1659x2212px.
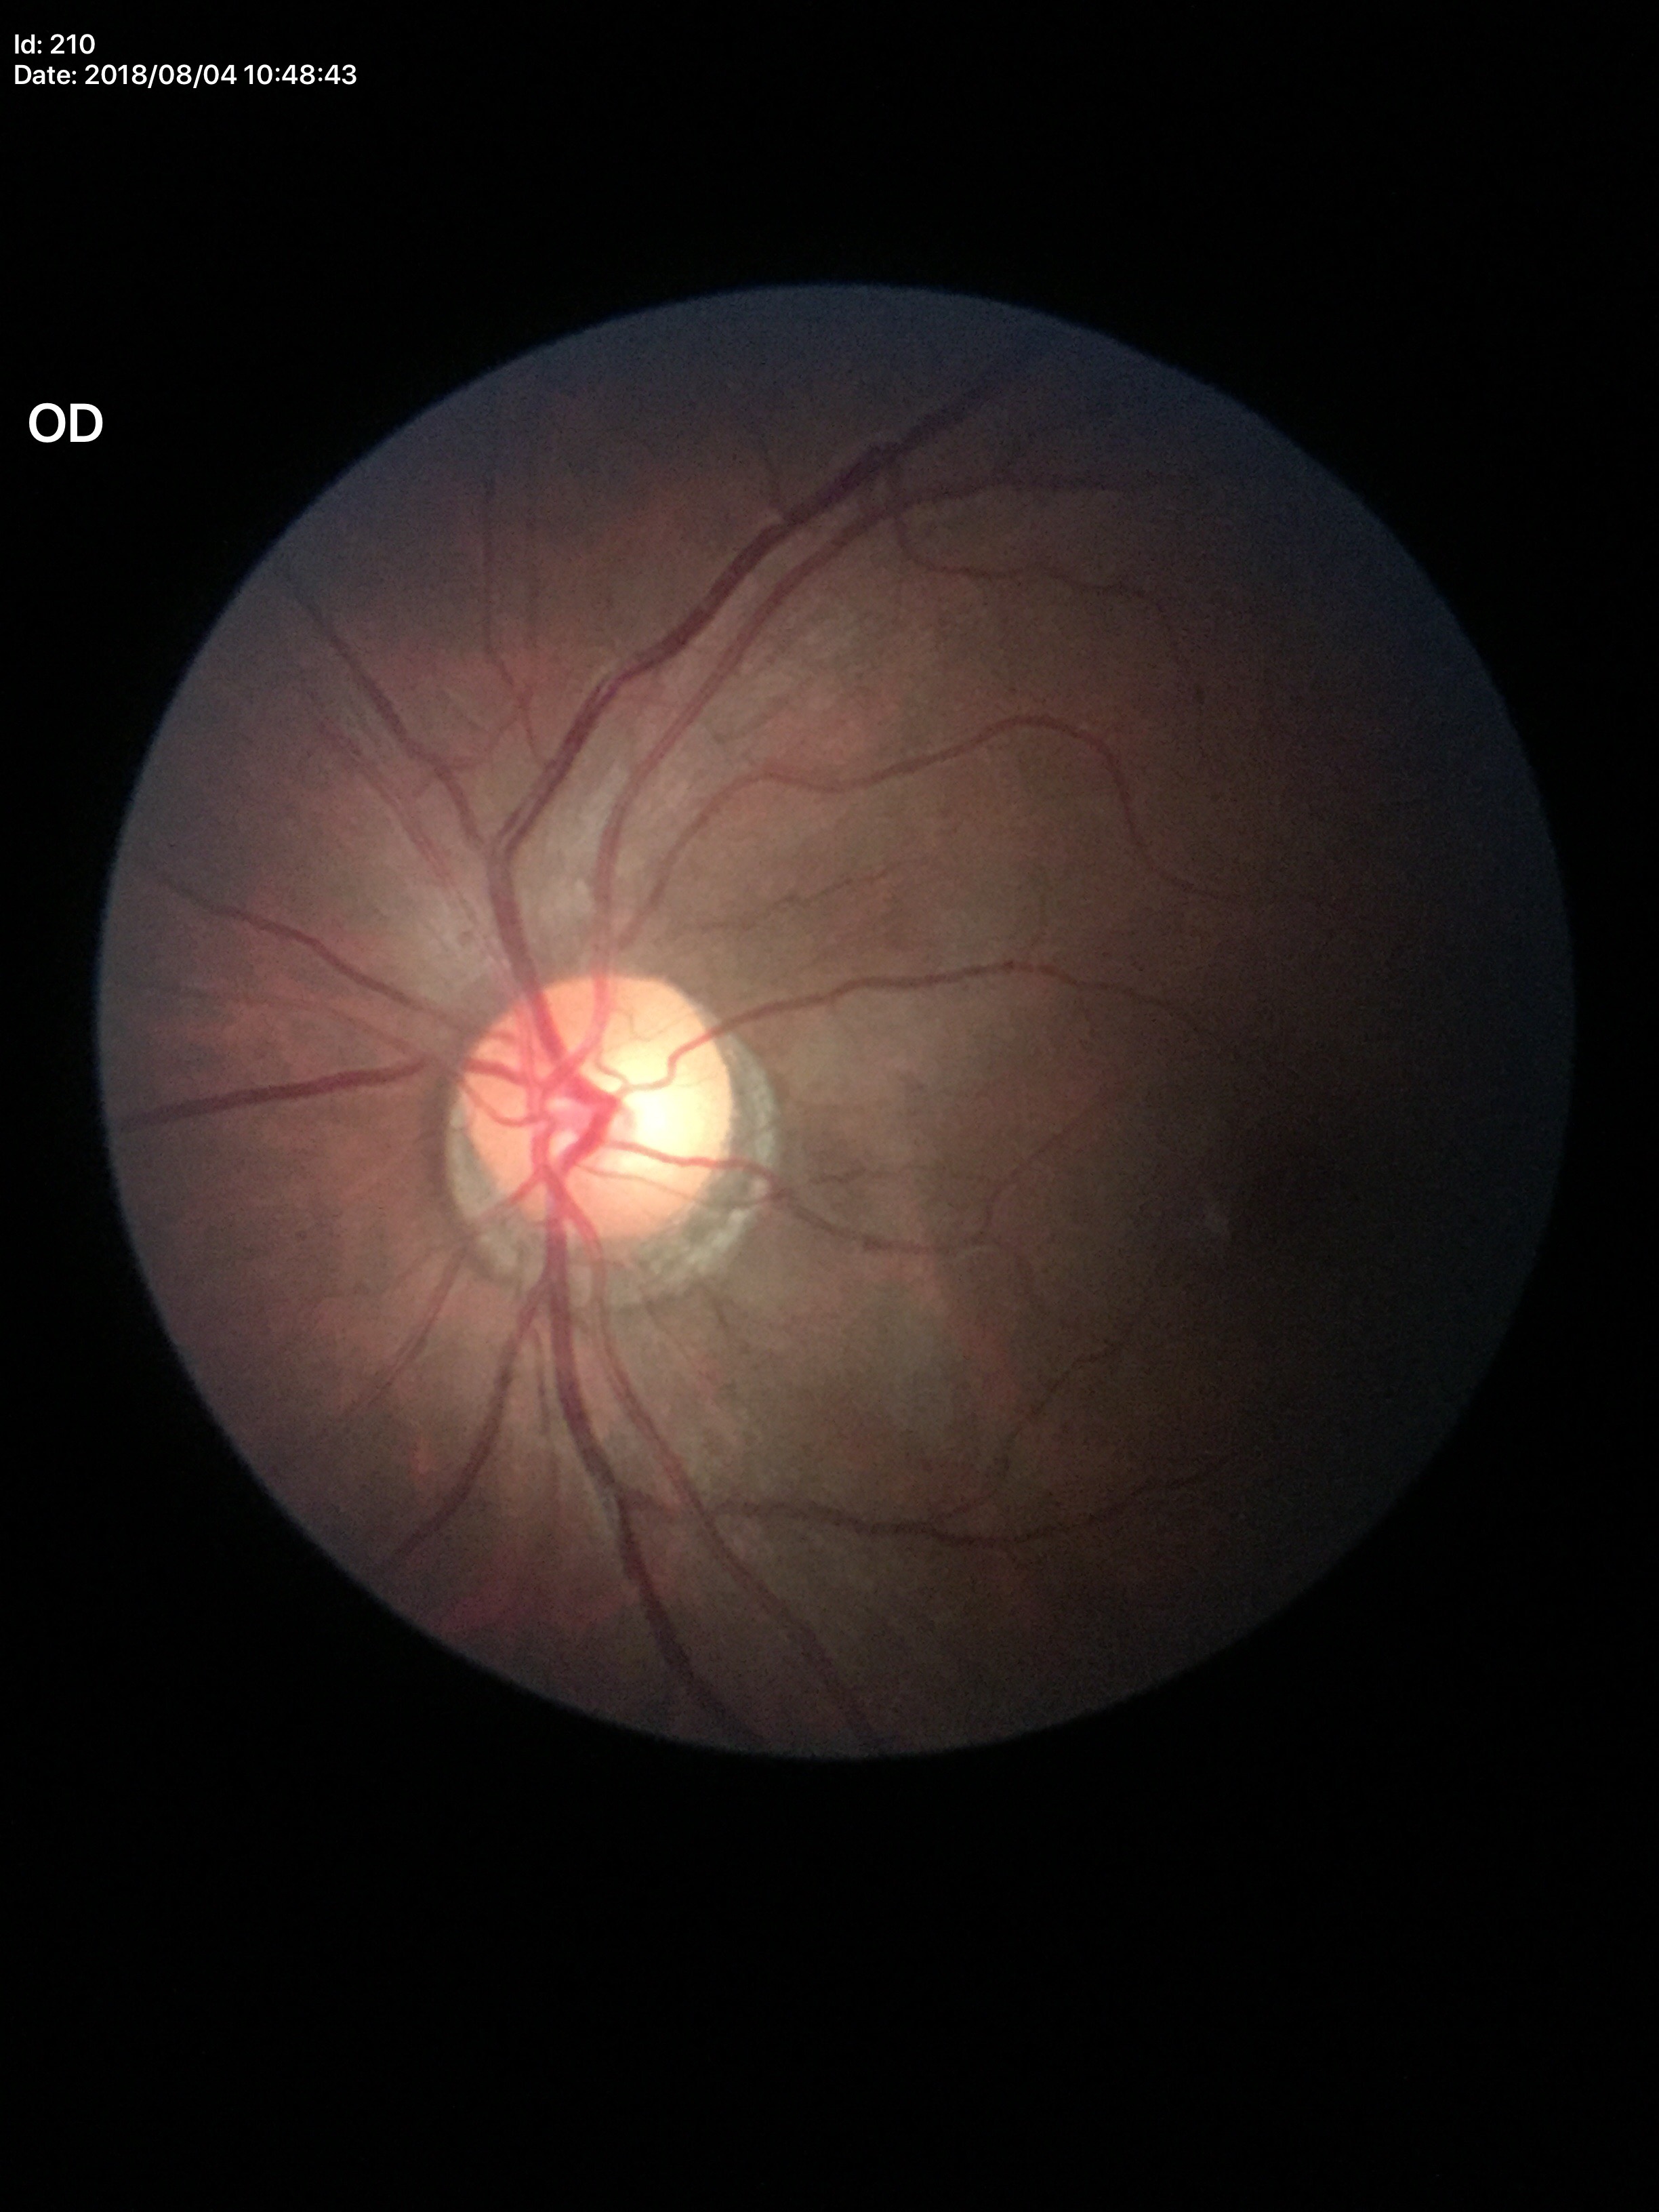
Glaucoma decision: not suspect (two of five ophthalmologists flagged glaucoma suspect). HCDR: 0.65. VCDR: 0.56.